Camera: Natus RetCam Envision (130° FOV) · wide-field fundus photograph from neonatal ROP screening · image size 1440x1080.
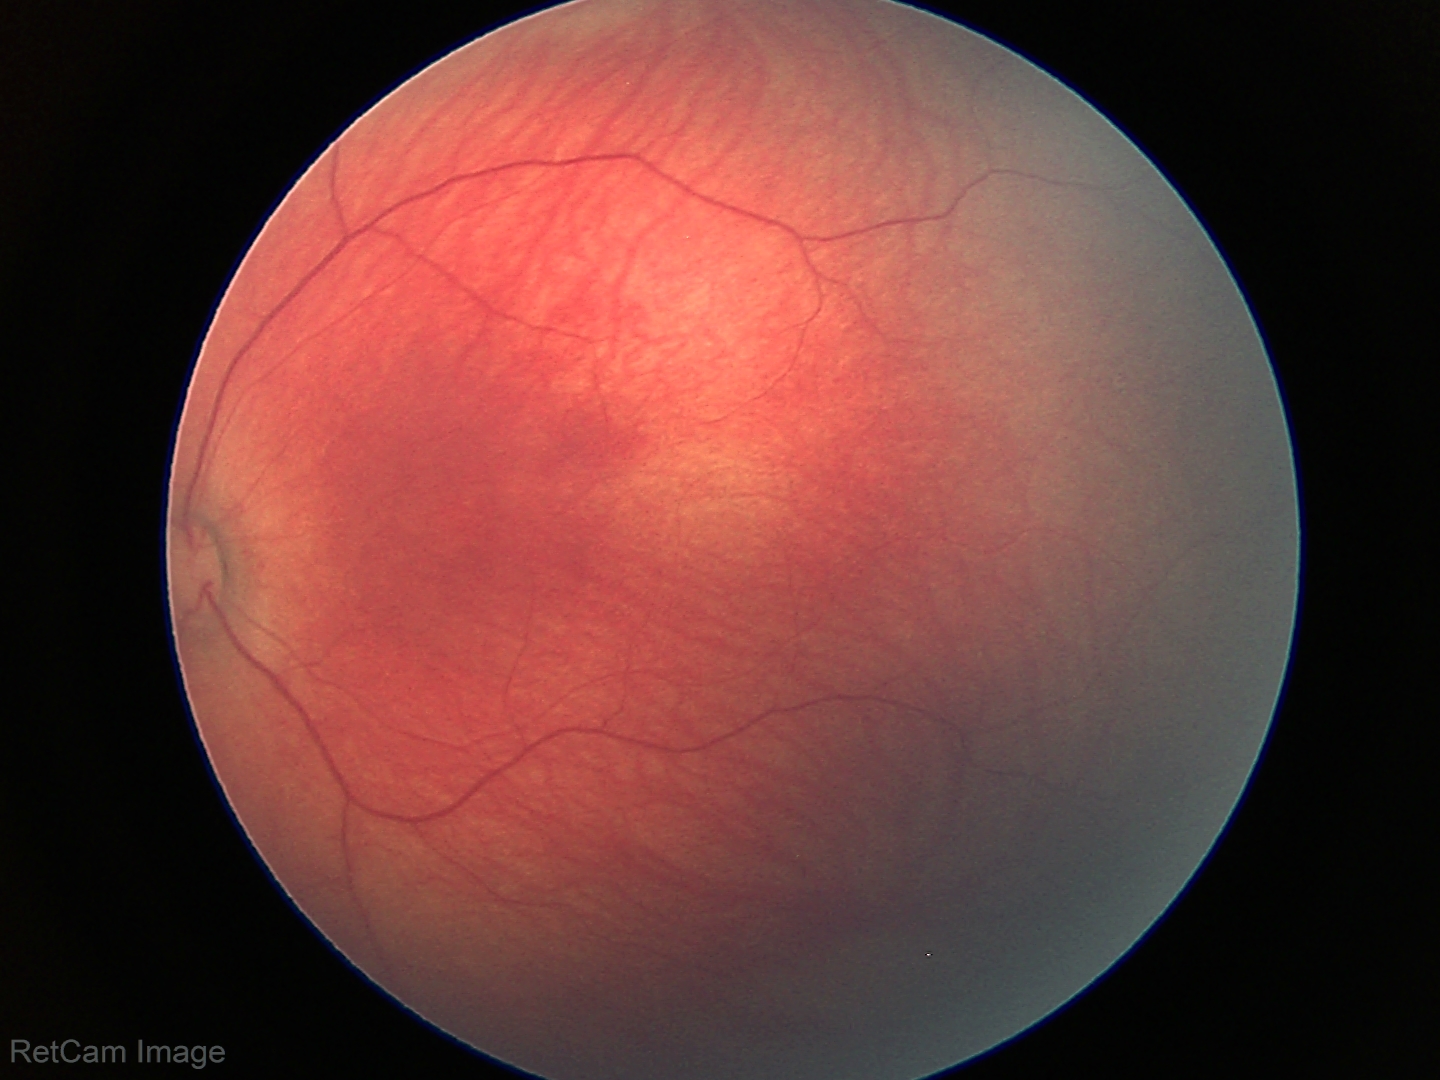
Screening: normal retinal appearance.